Color fundus photograph:
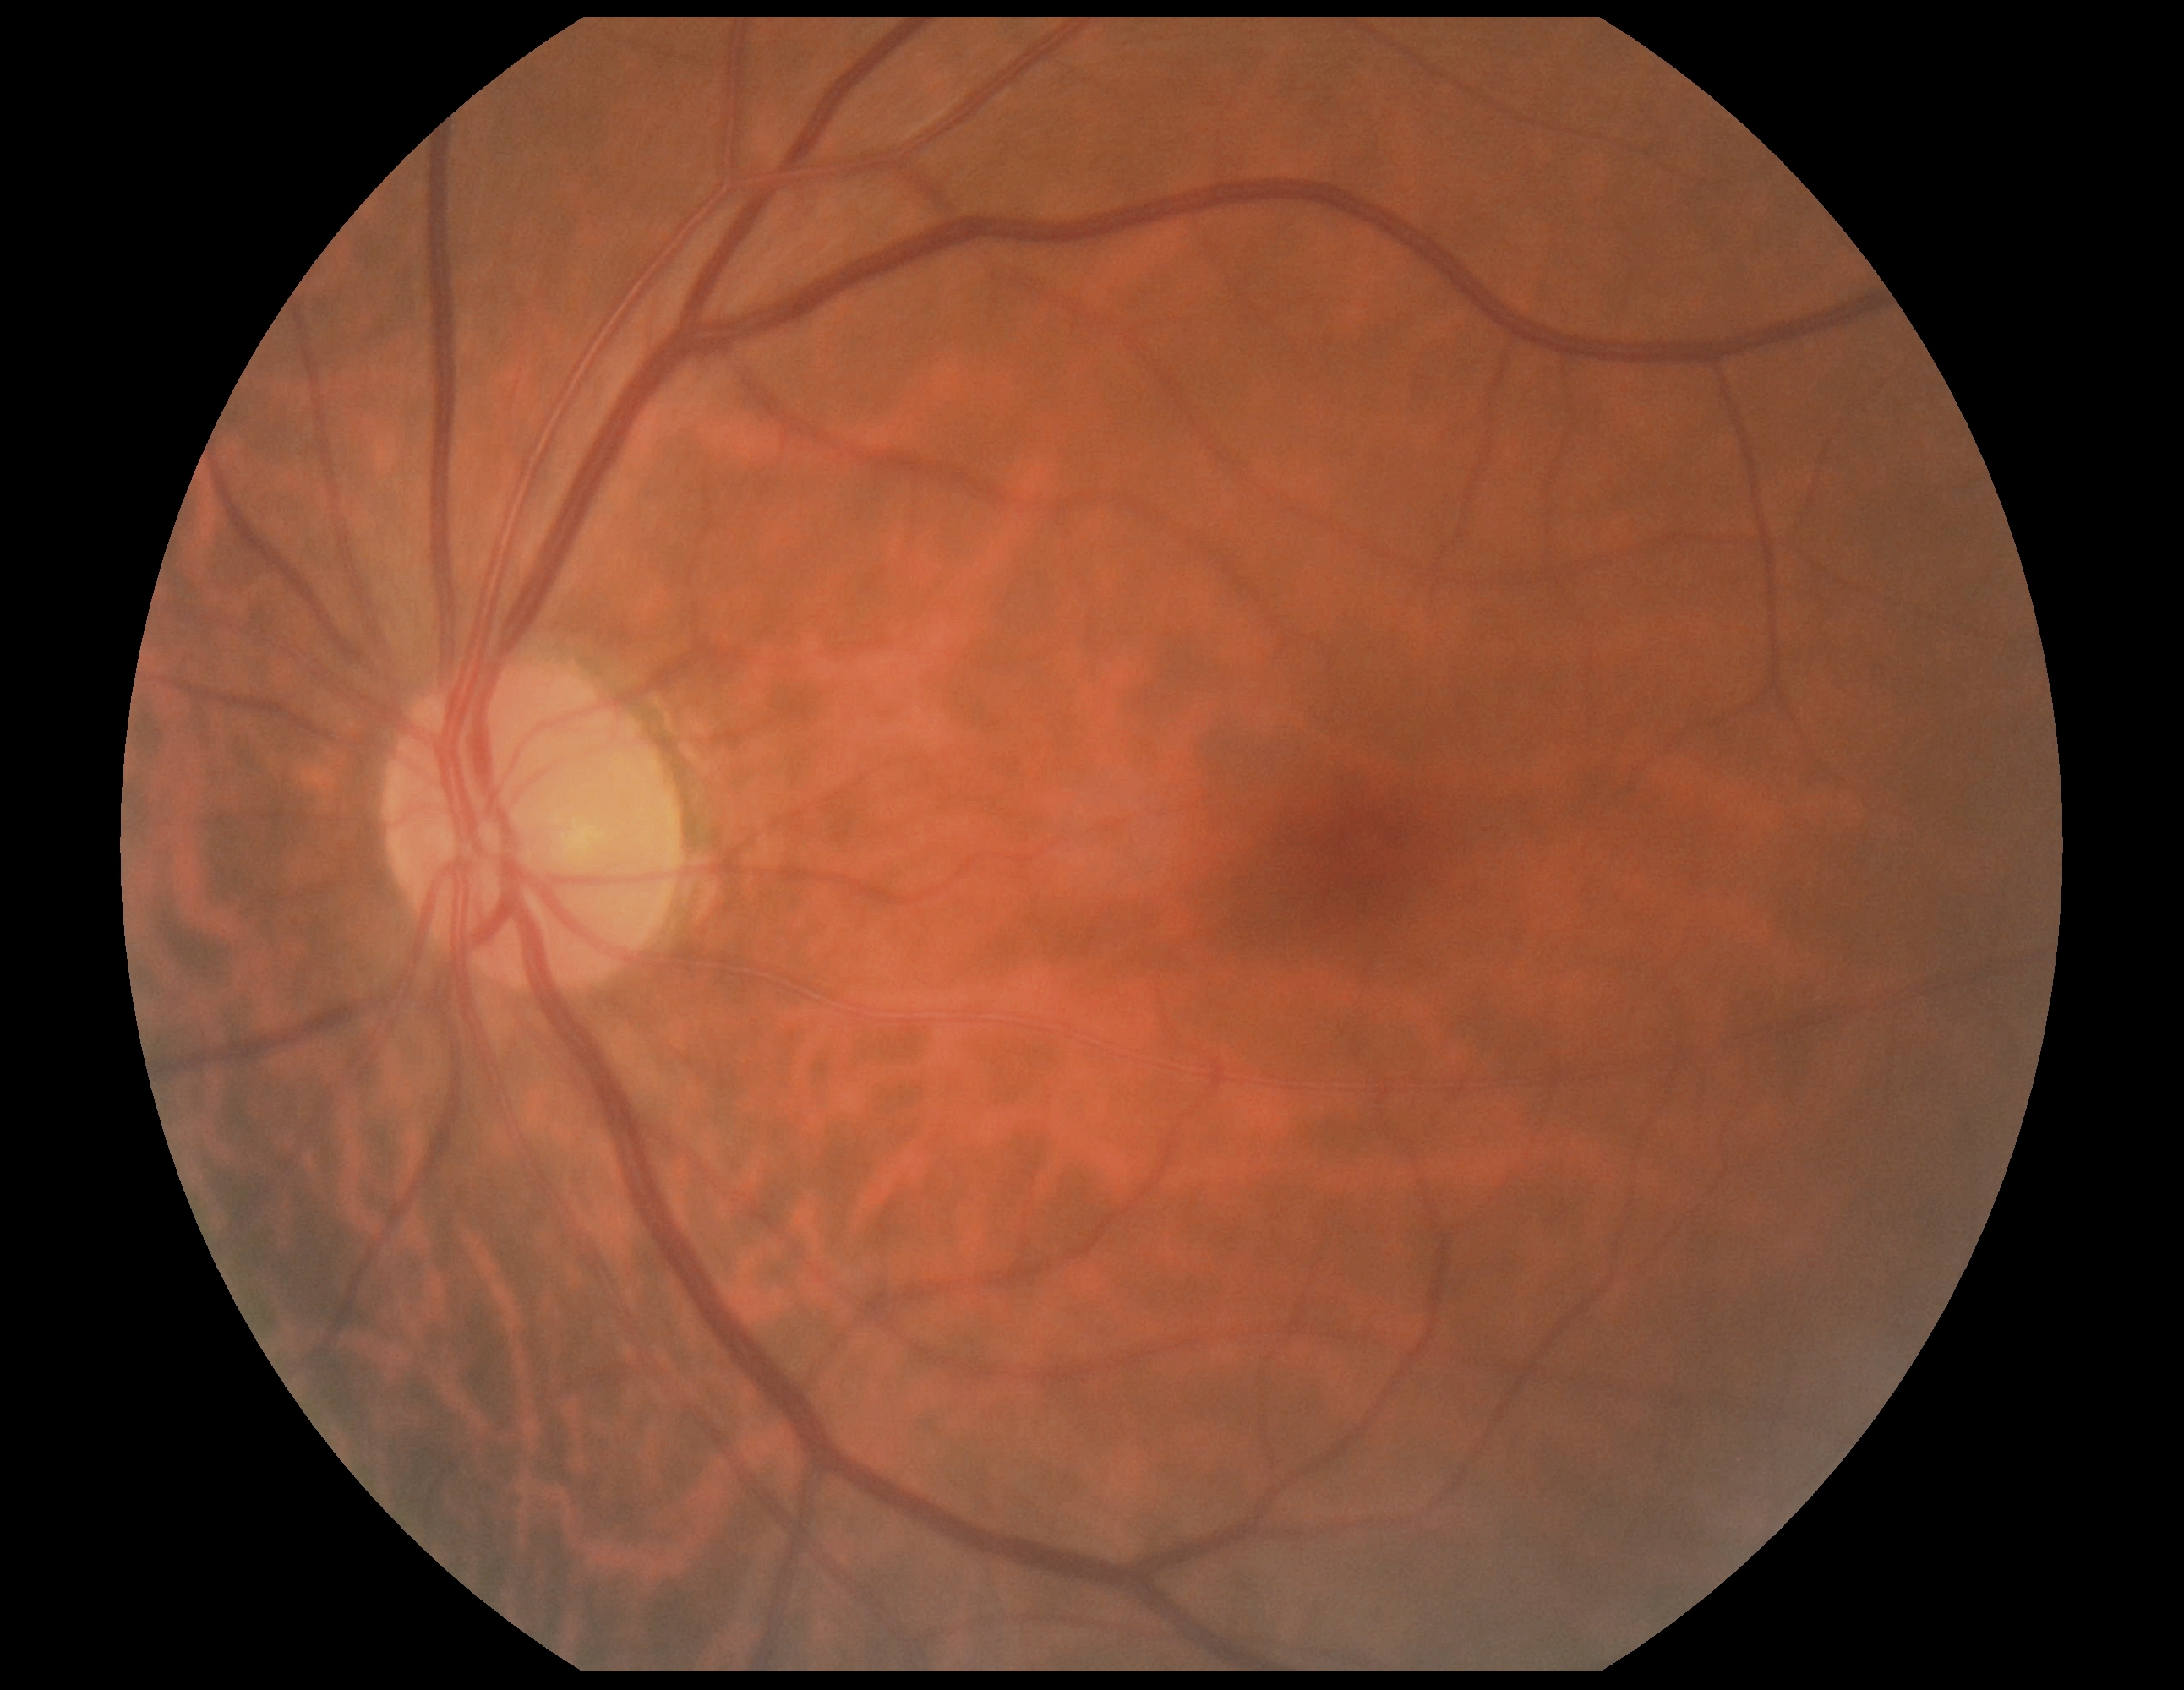
{
  "dr_grade": "no apparent retinopathy (grade 0)"
}